Modified Davis grading.
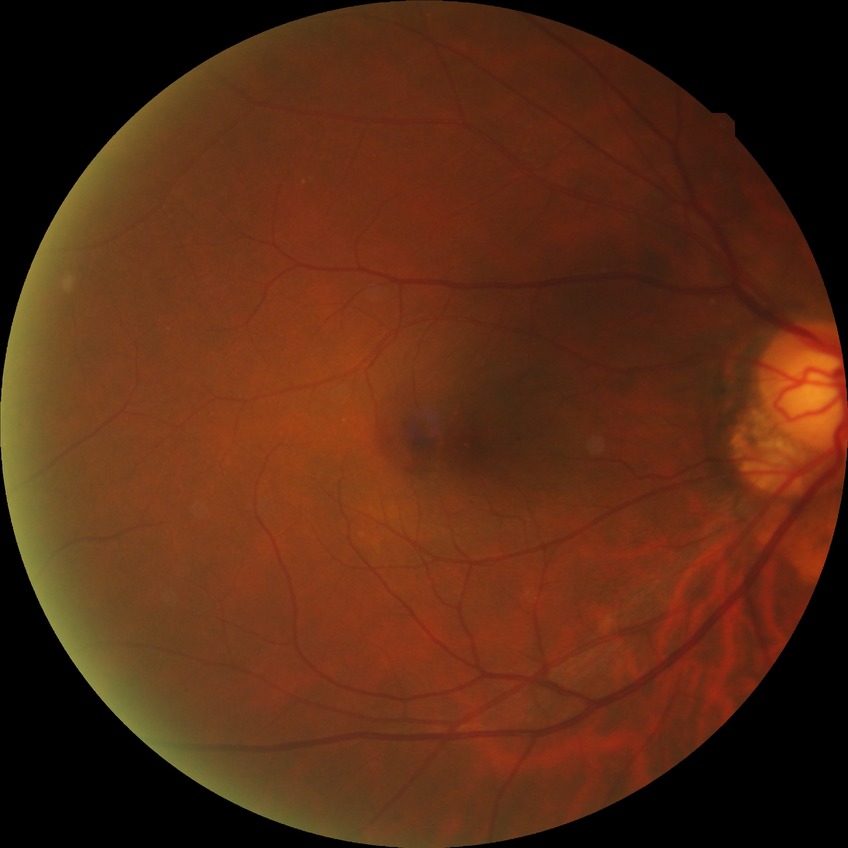
Diabetic retinopathy grade is no diabetic retinopathy.